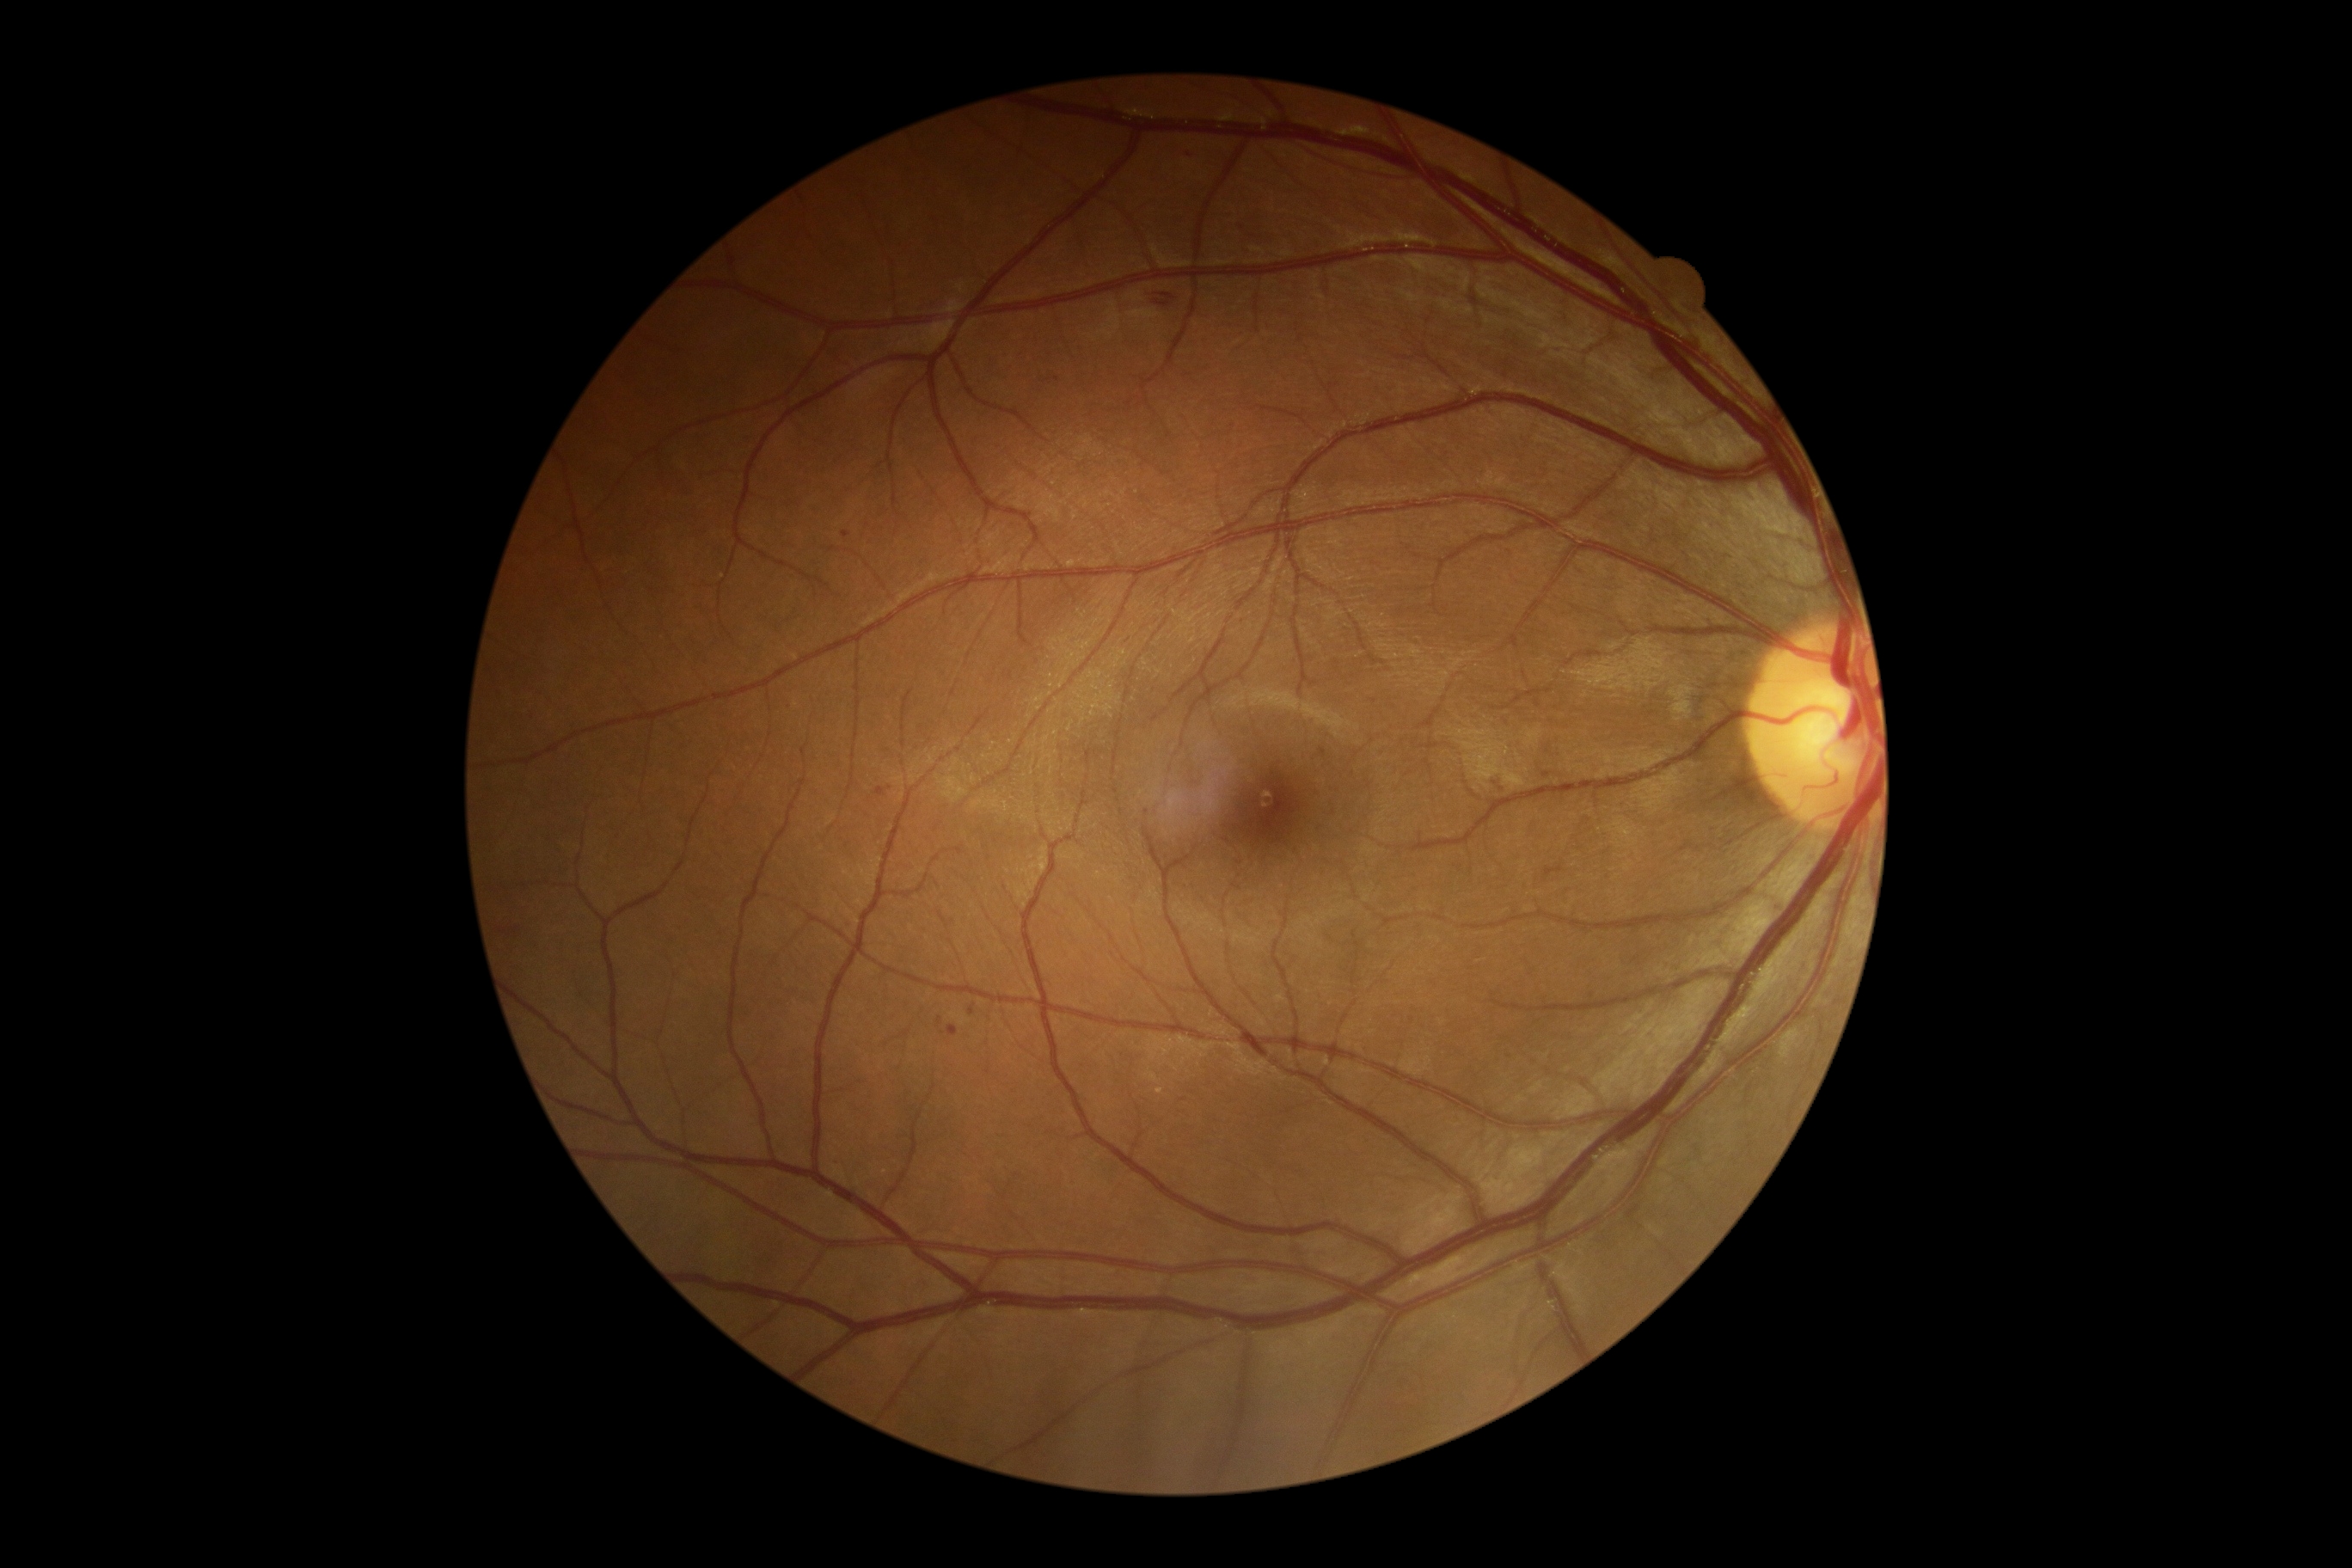 The retinopathy is classified as non-proliferative diabetic retinopathy. Diabetic retinopathy is 2/4.